640x480px · infant wide-field fundus photograph · camera: Clarity RetCam 3 (130° FOV).
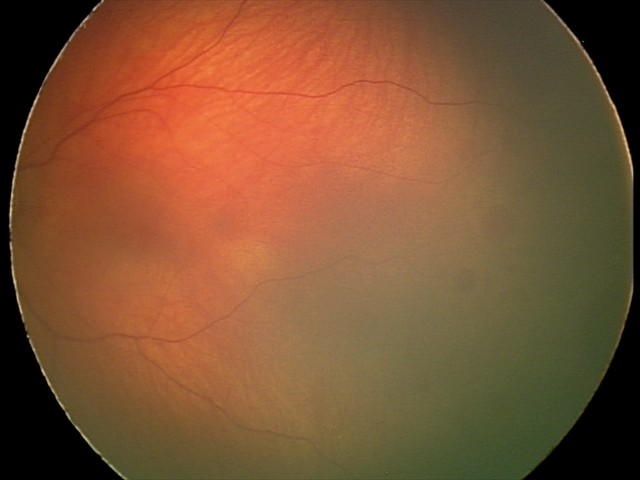

Examination diagnosed as retinal hemorrhages.